Captured with the Phoenix ICON (100° field of view); image size 1240x1240; Phoenix ICON wide-field infant fundus image.
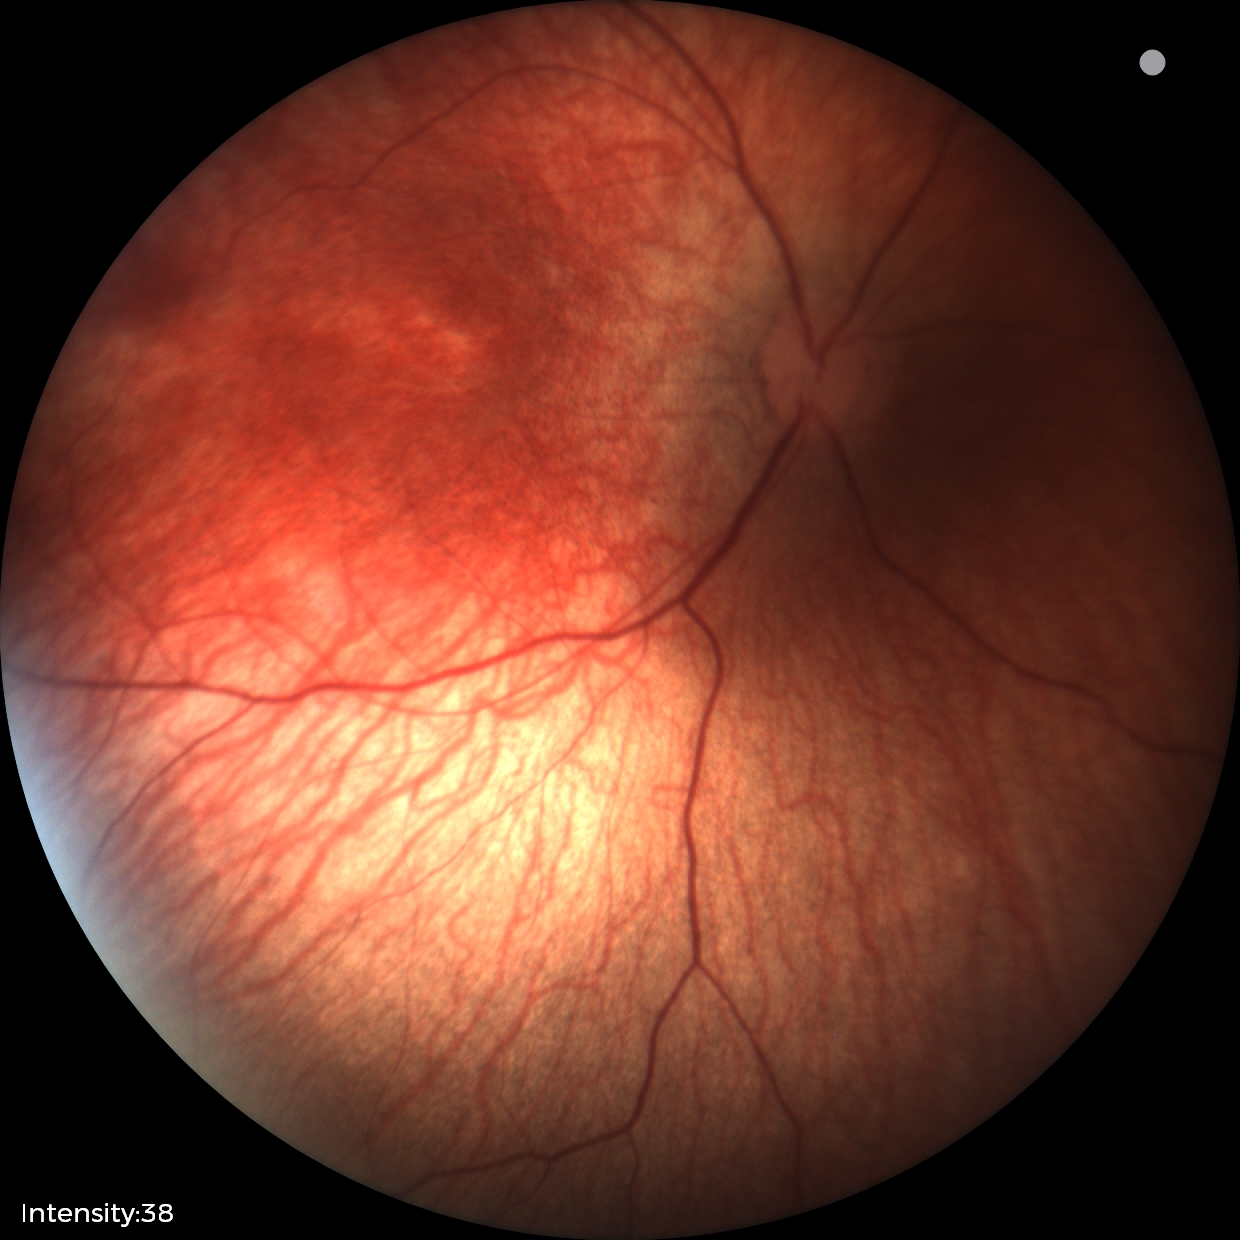

Diagnosis = no pathology identified.